Color fundus image · 2048 by 1536 pixels · 45-degree field of view — 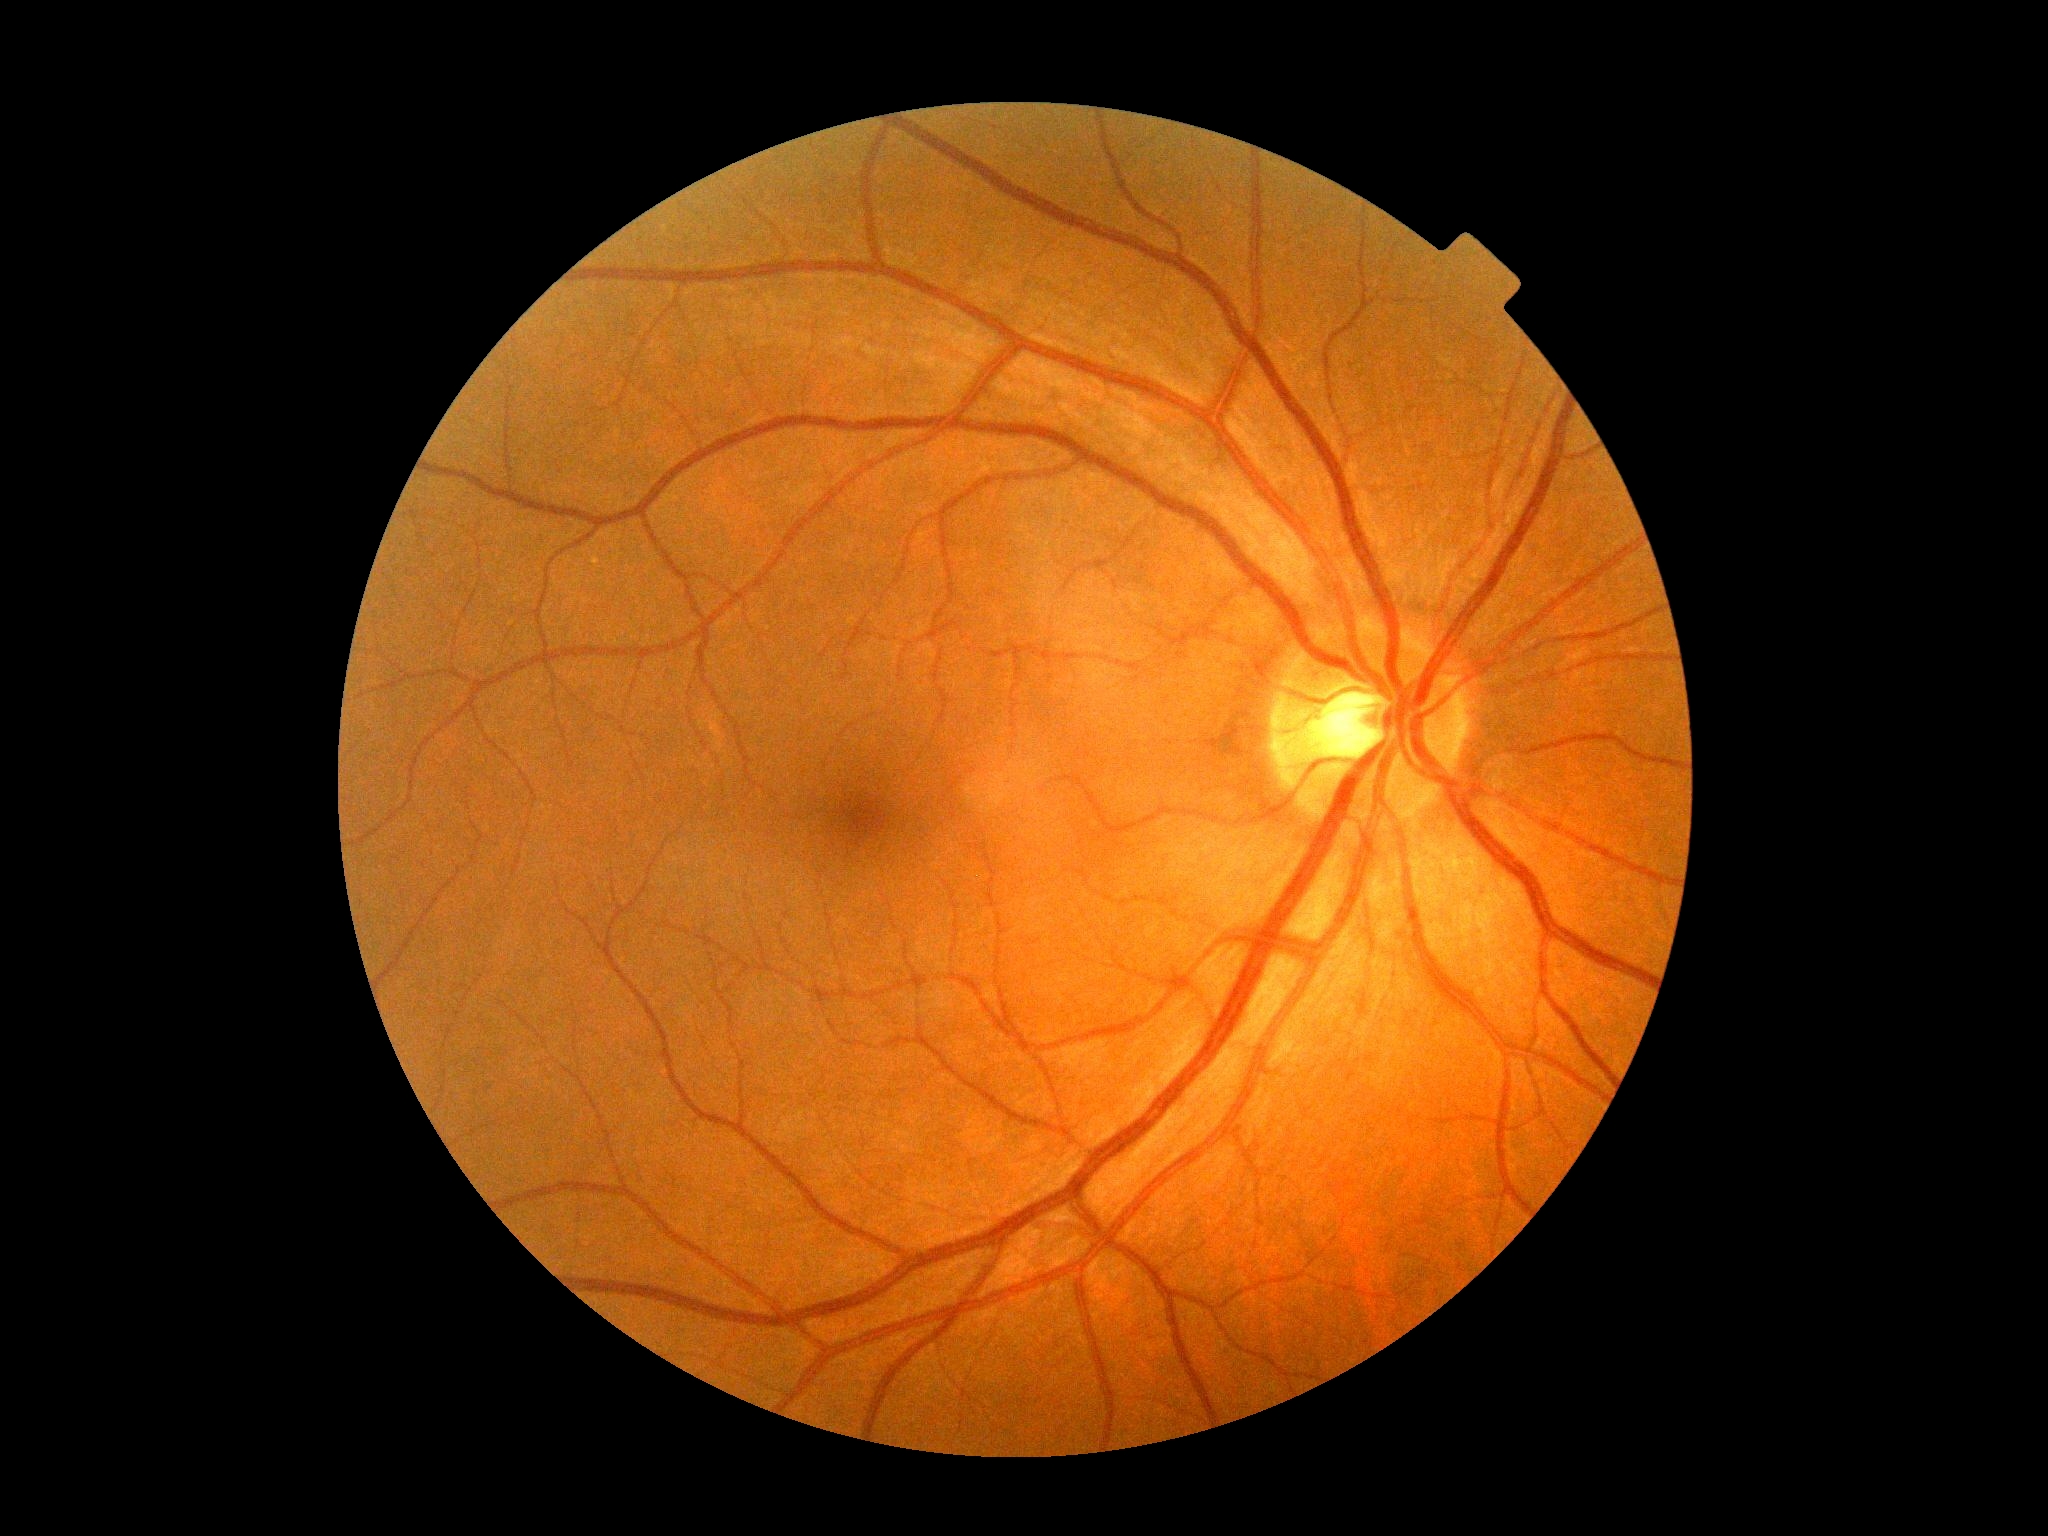
Diabetic retinopathy is 0.